FOV: 45 degrees · DR severity per modified Davis staging · camera: NIDEK AFC-230 · CFP · without pupil dilation
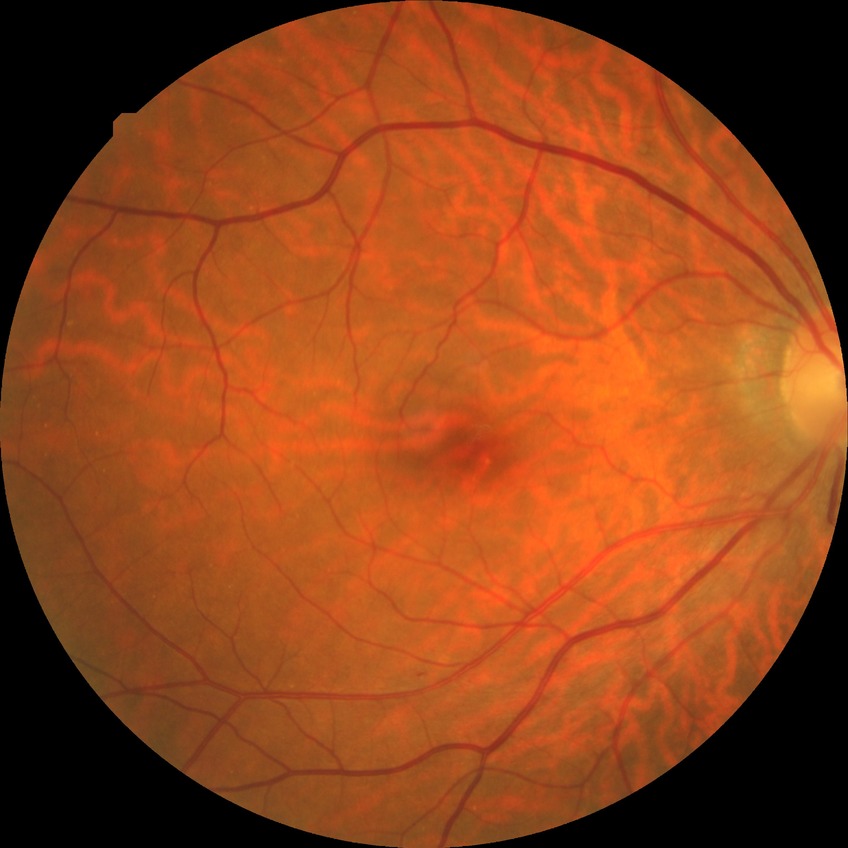

DR grade is SDR.